Fundus photo; 2352x1568; FOV: 45 degrees — 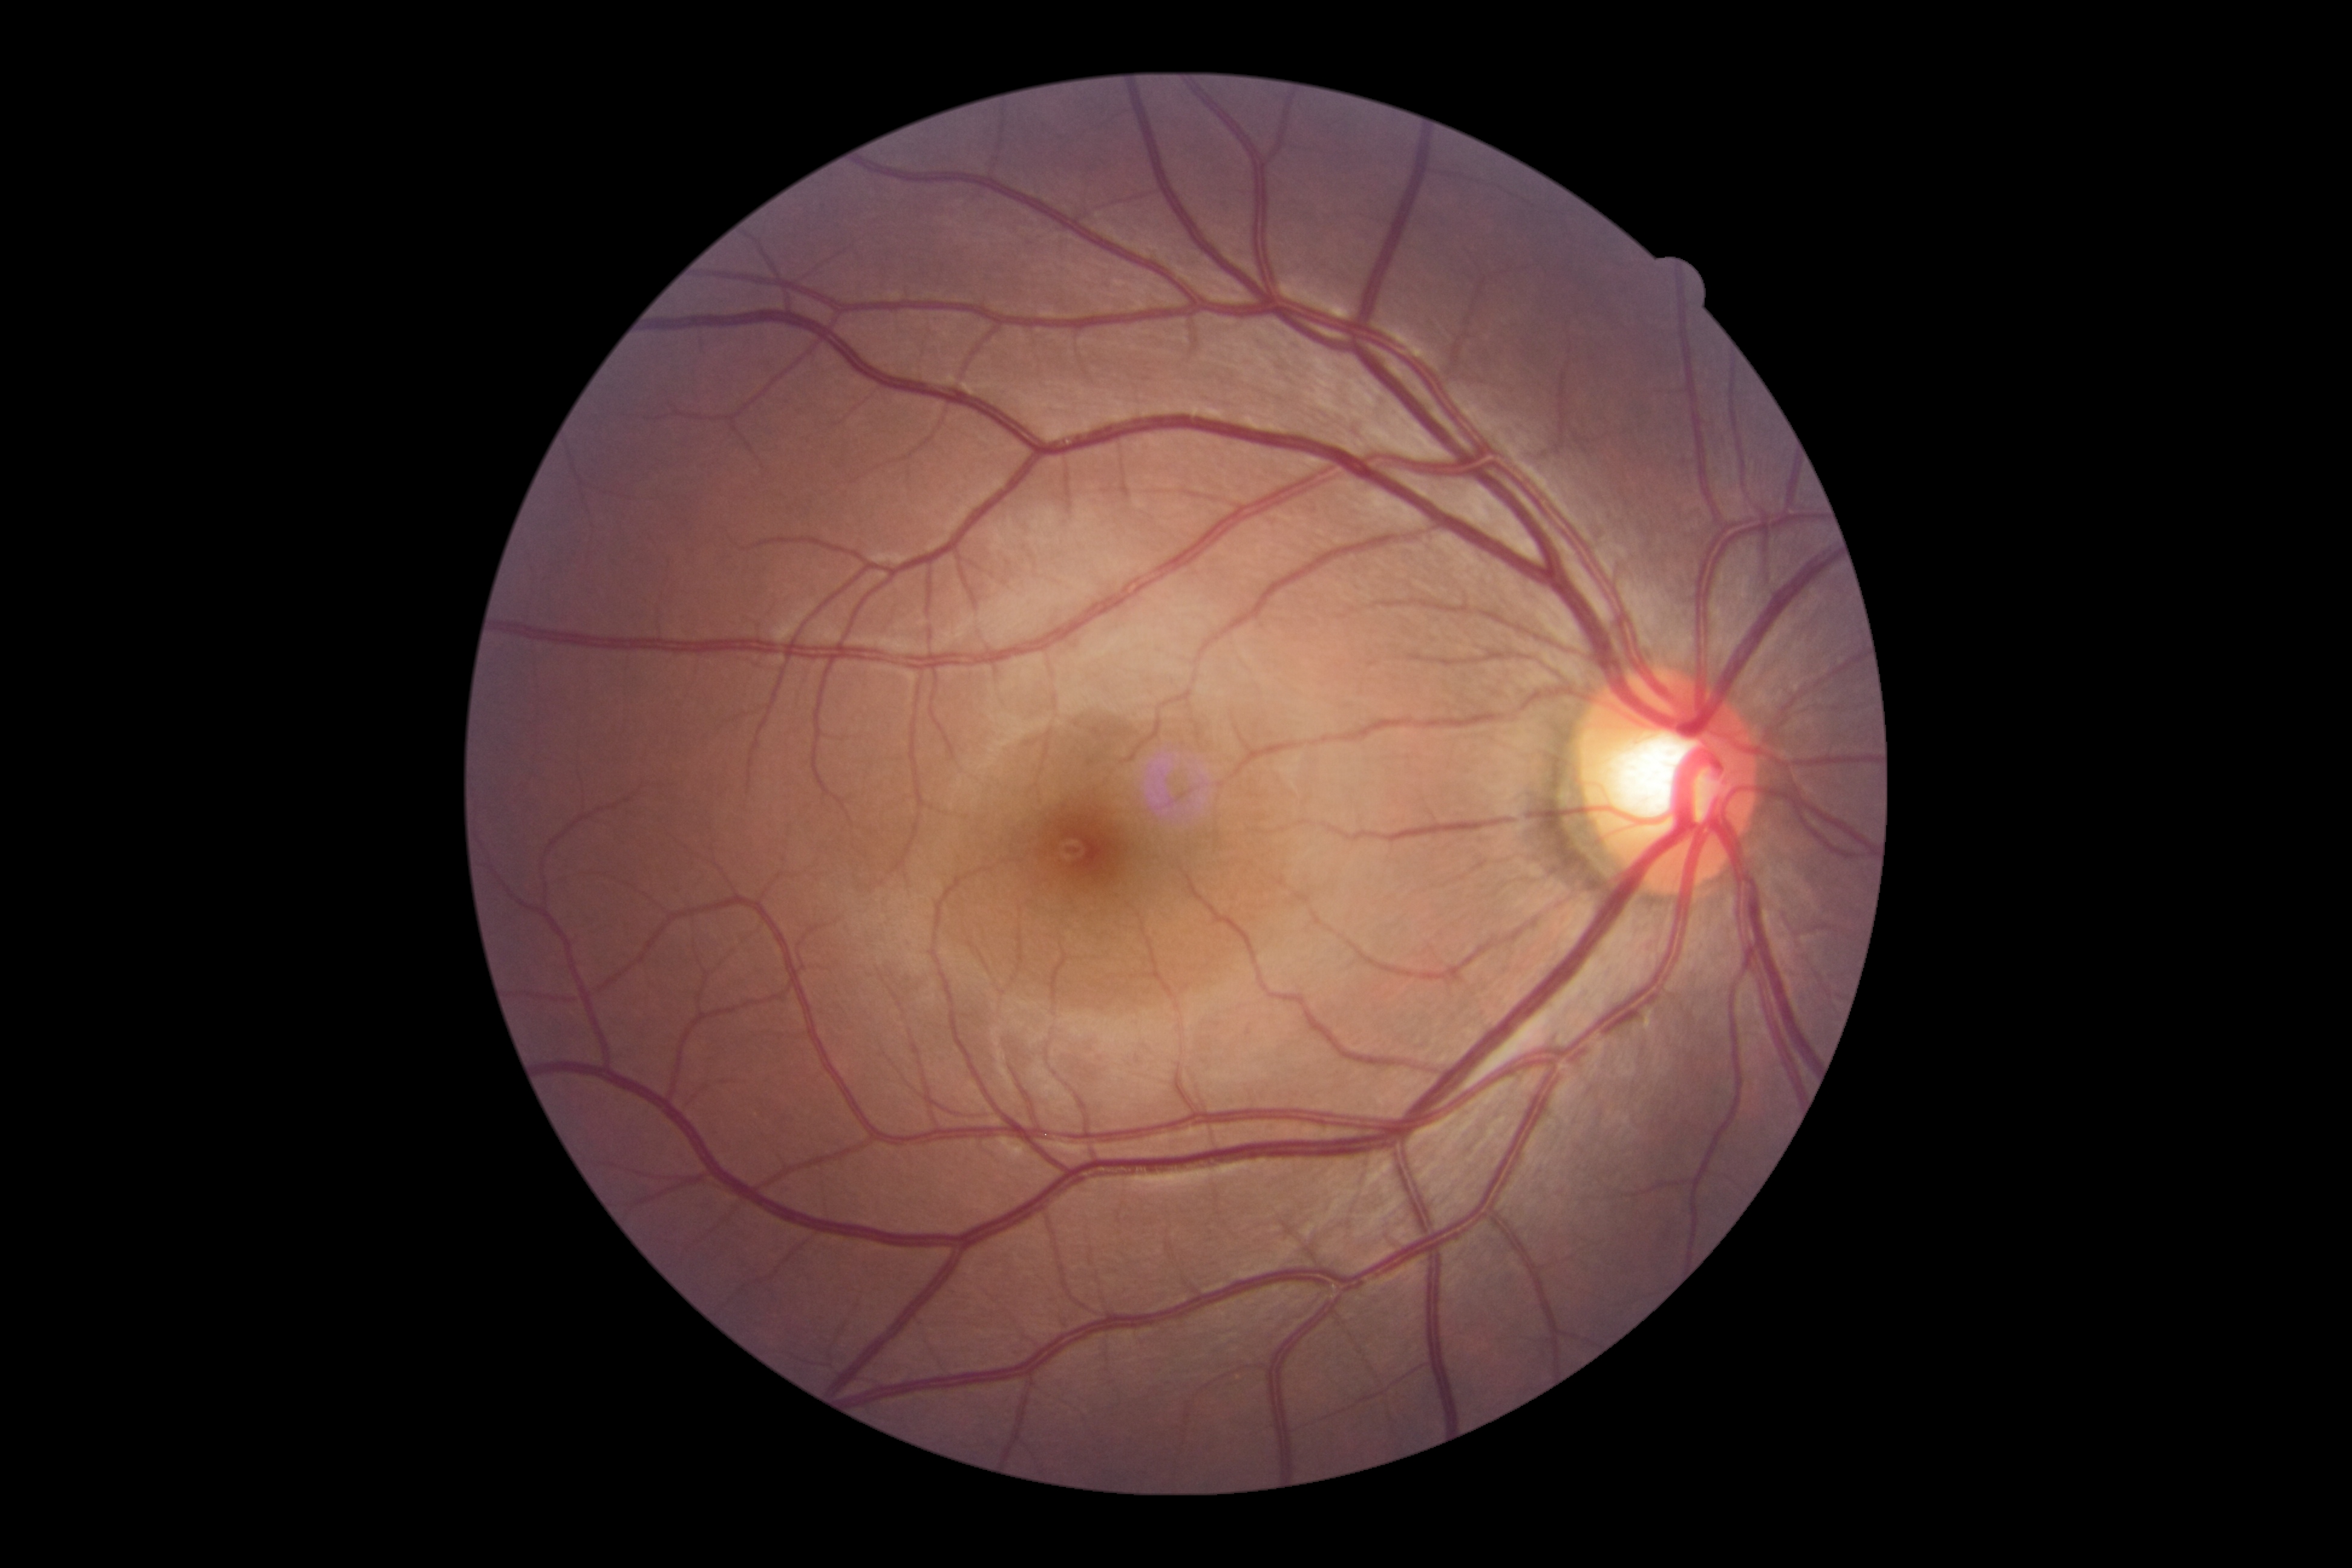

Diabetic retinopathy (DR): 0.